Color fundus image · image size 2352x1568
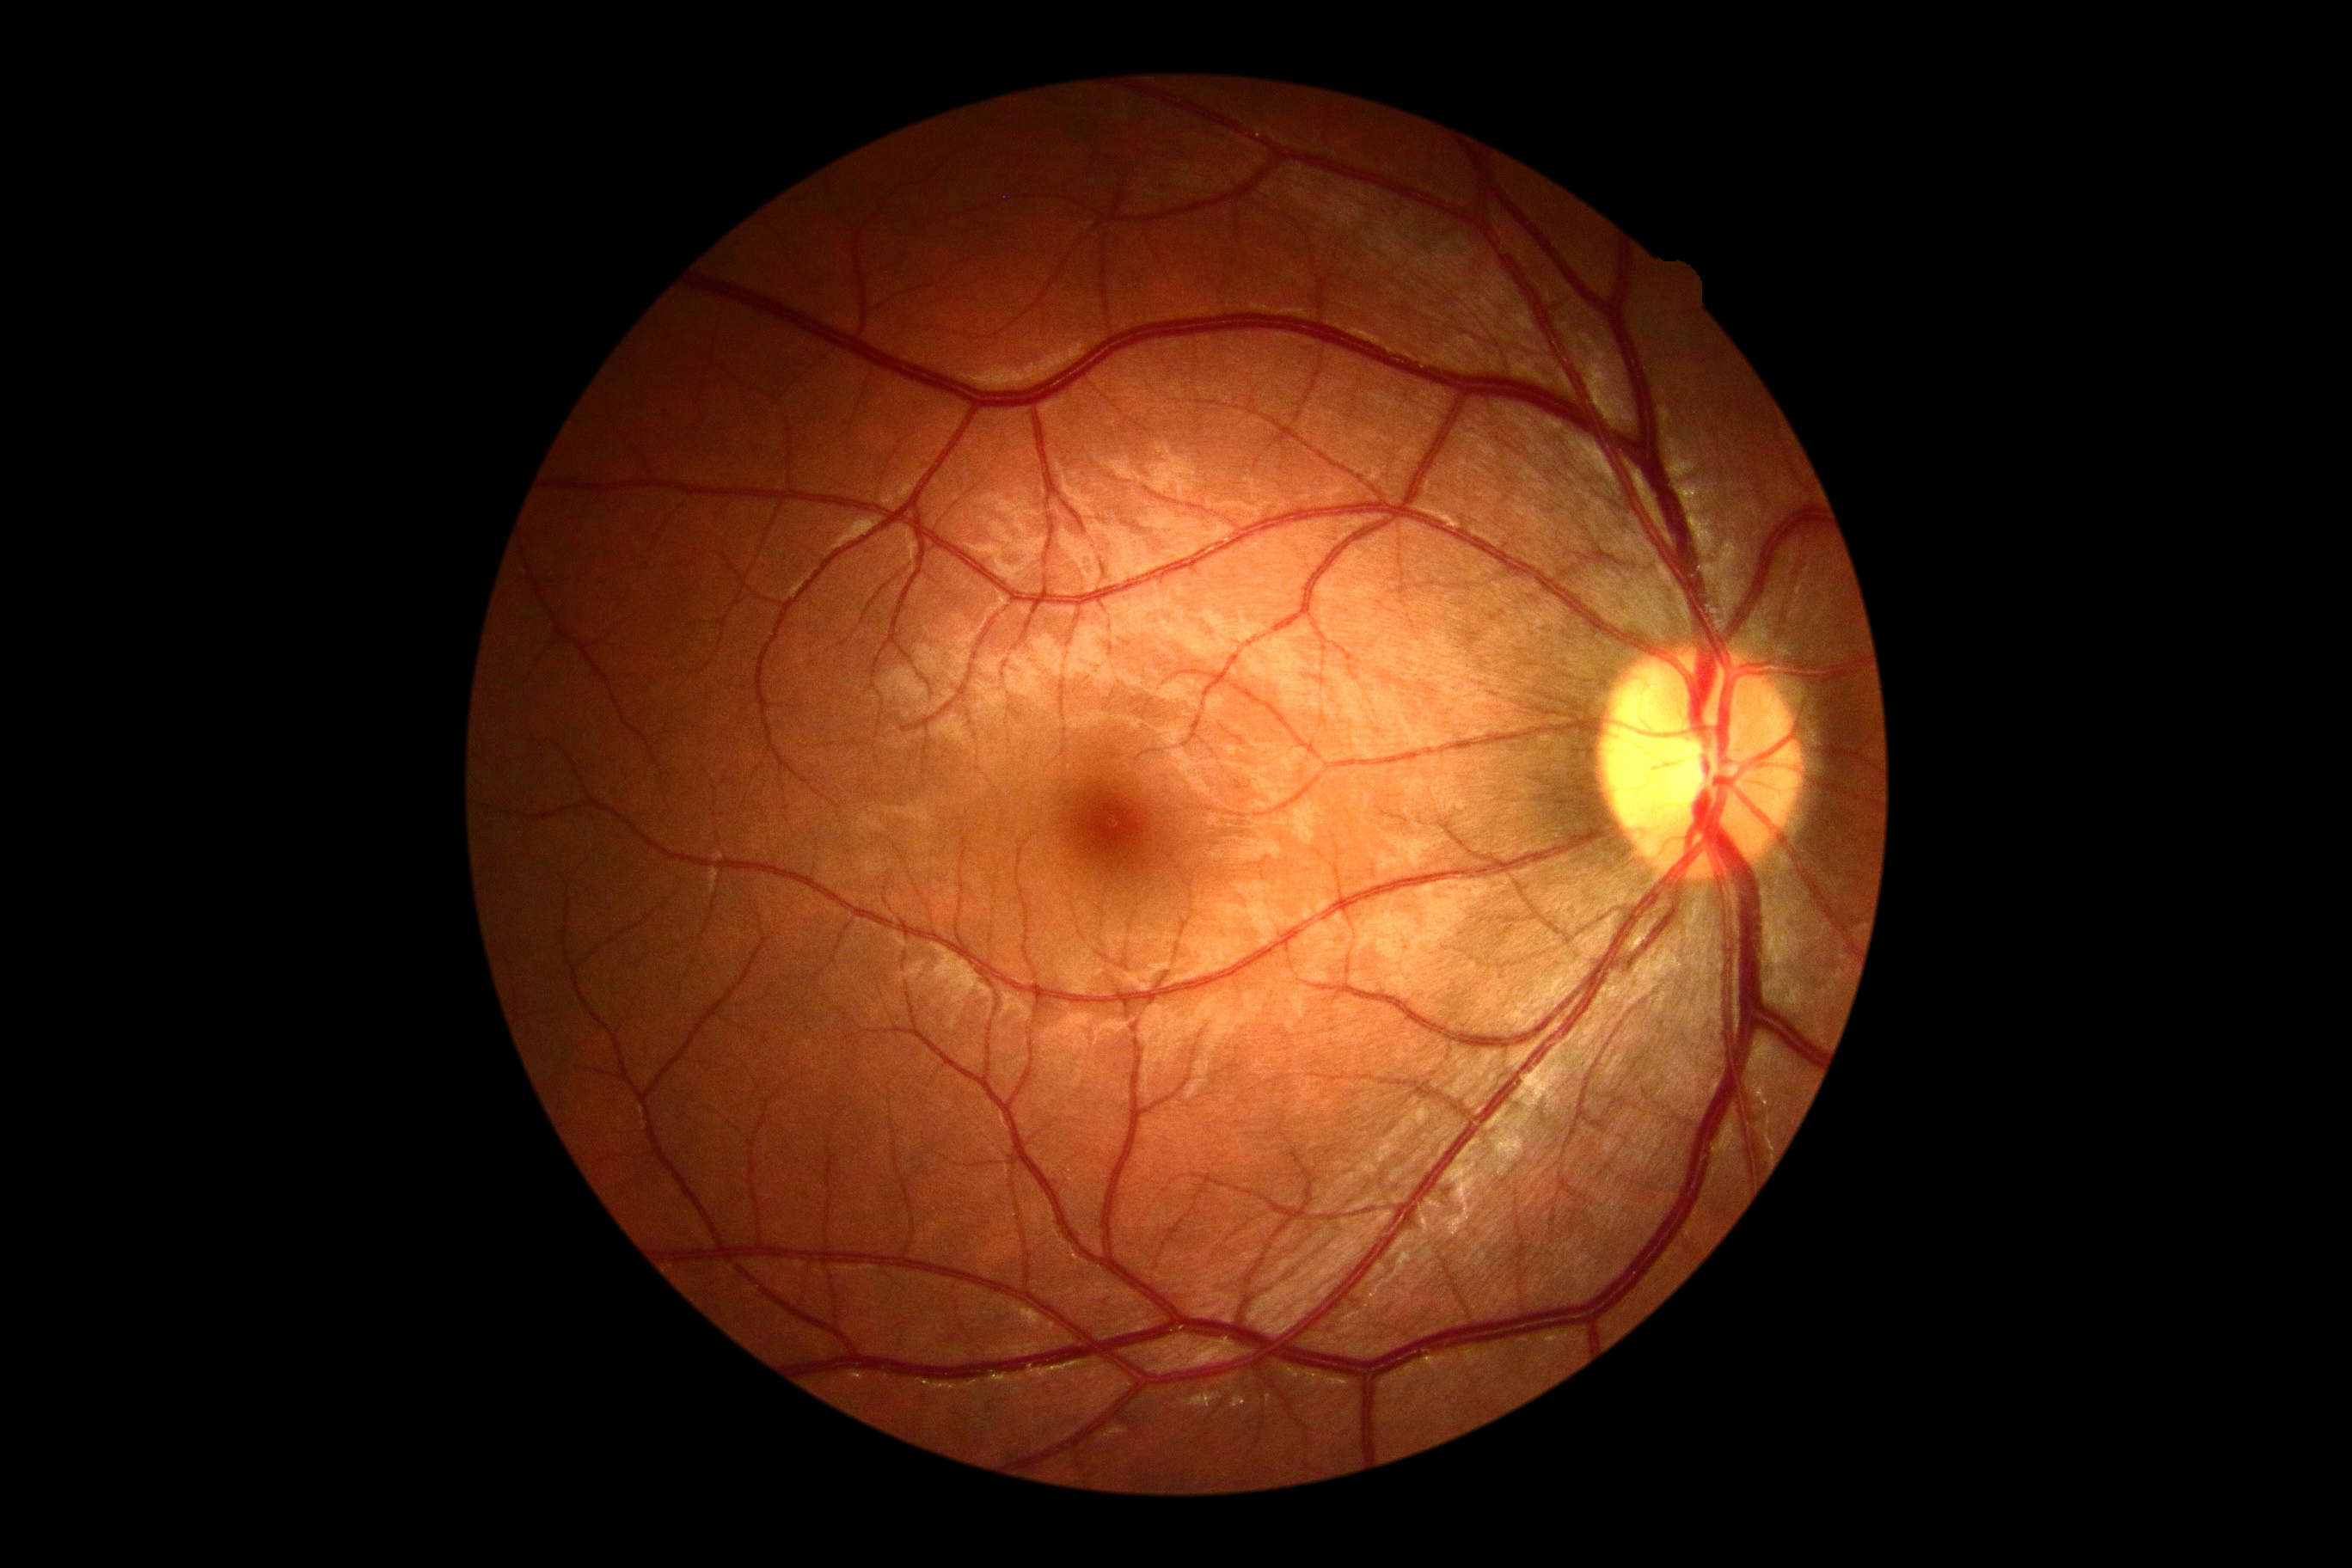

No diabetic retinal disease findings.
Diabetic retinopathy (DR): no apparent diabetic retinopathy (grade 0).